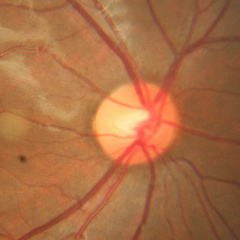 Q: Does this eye have glaucoma?
A: No glaucoma.